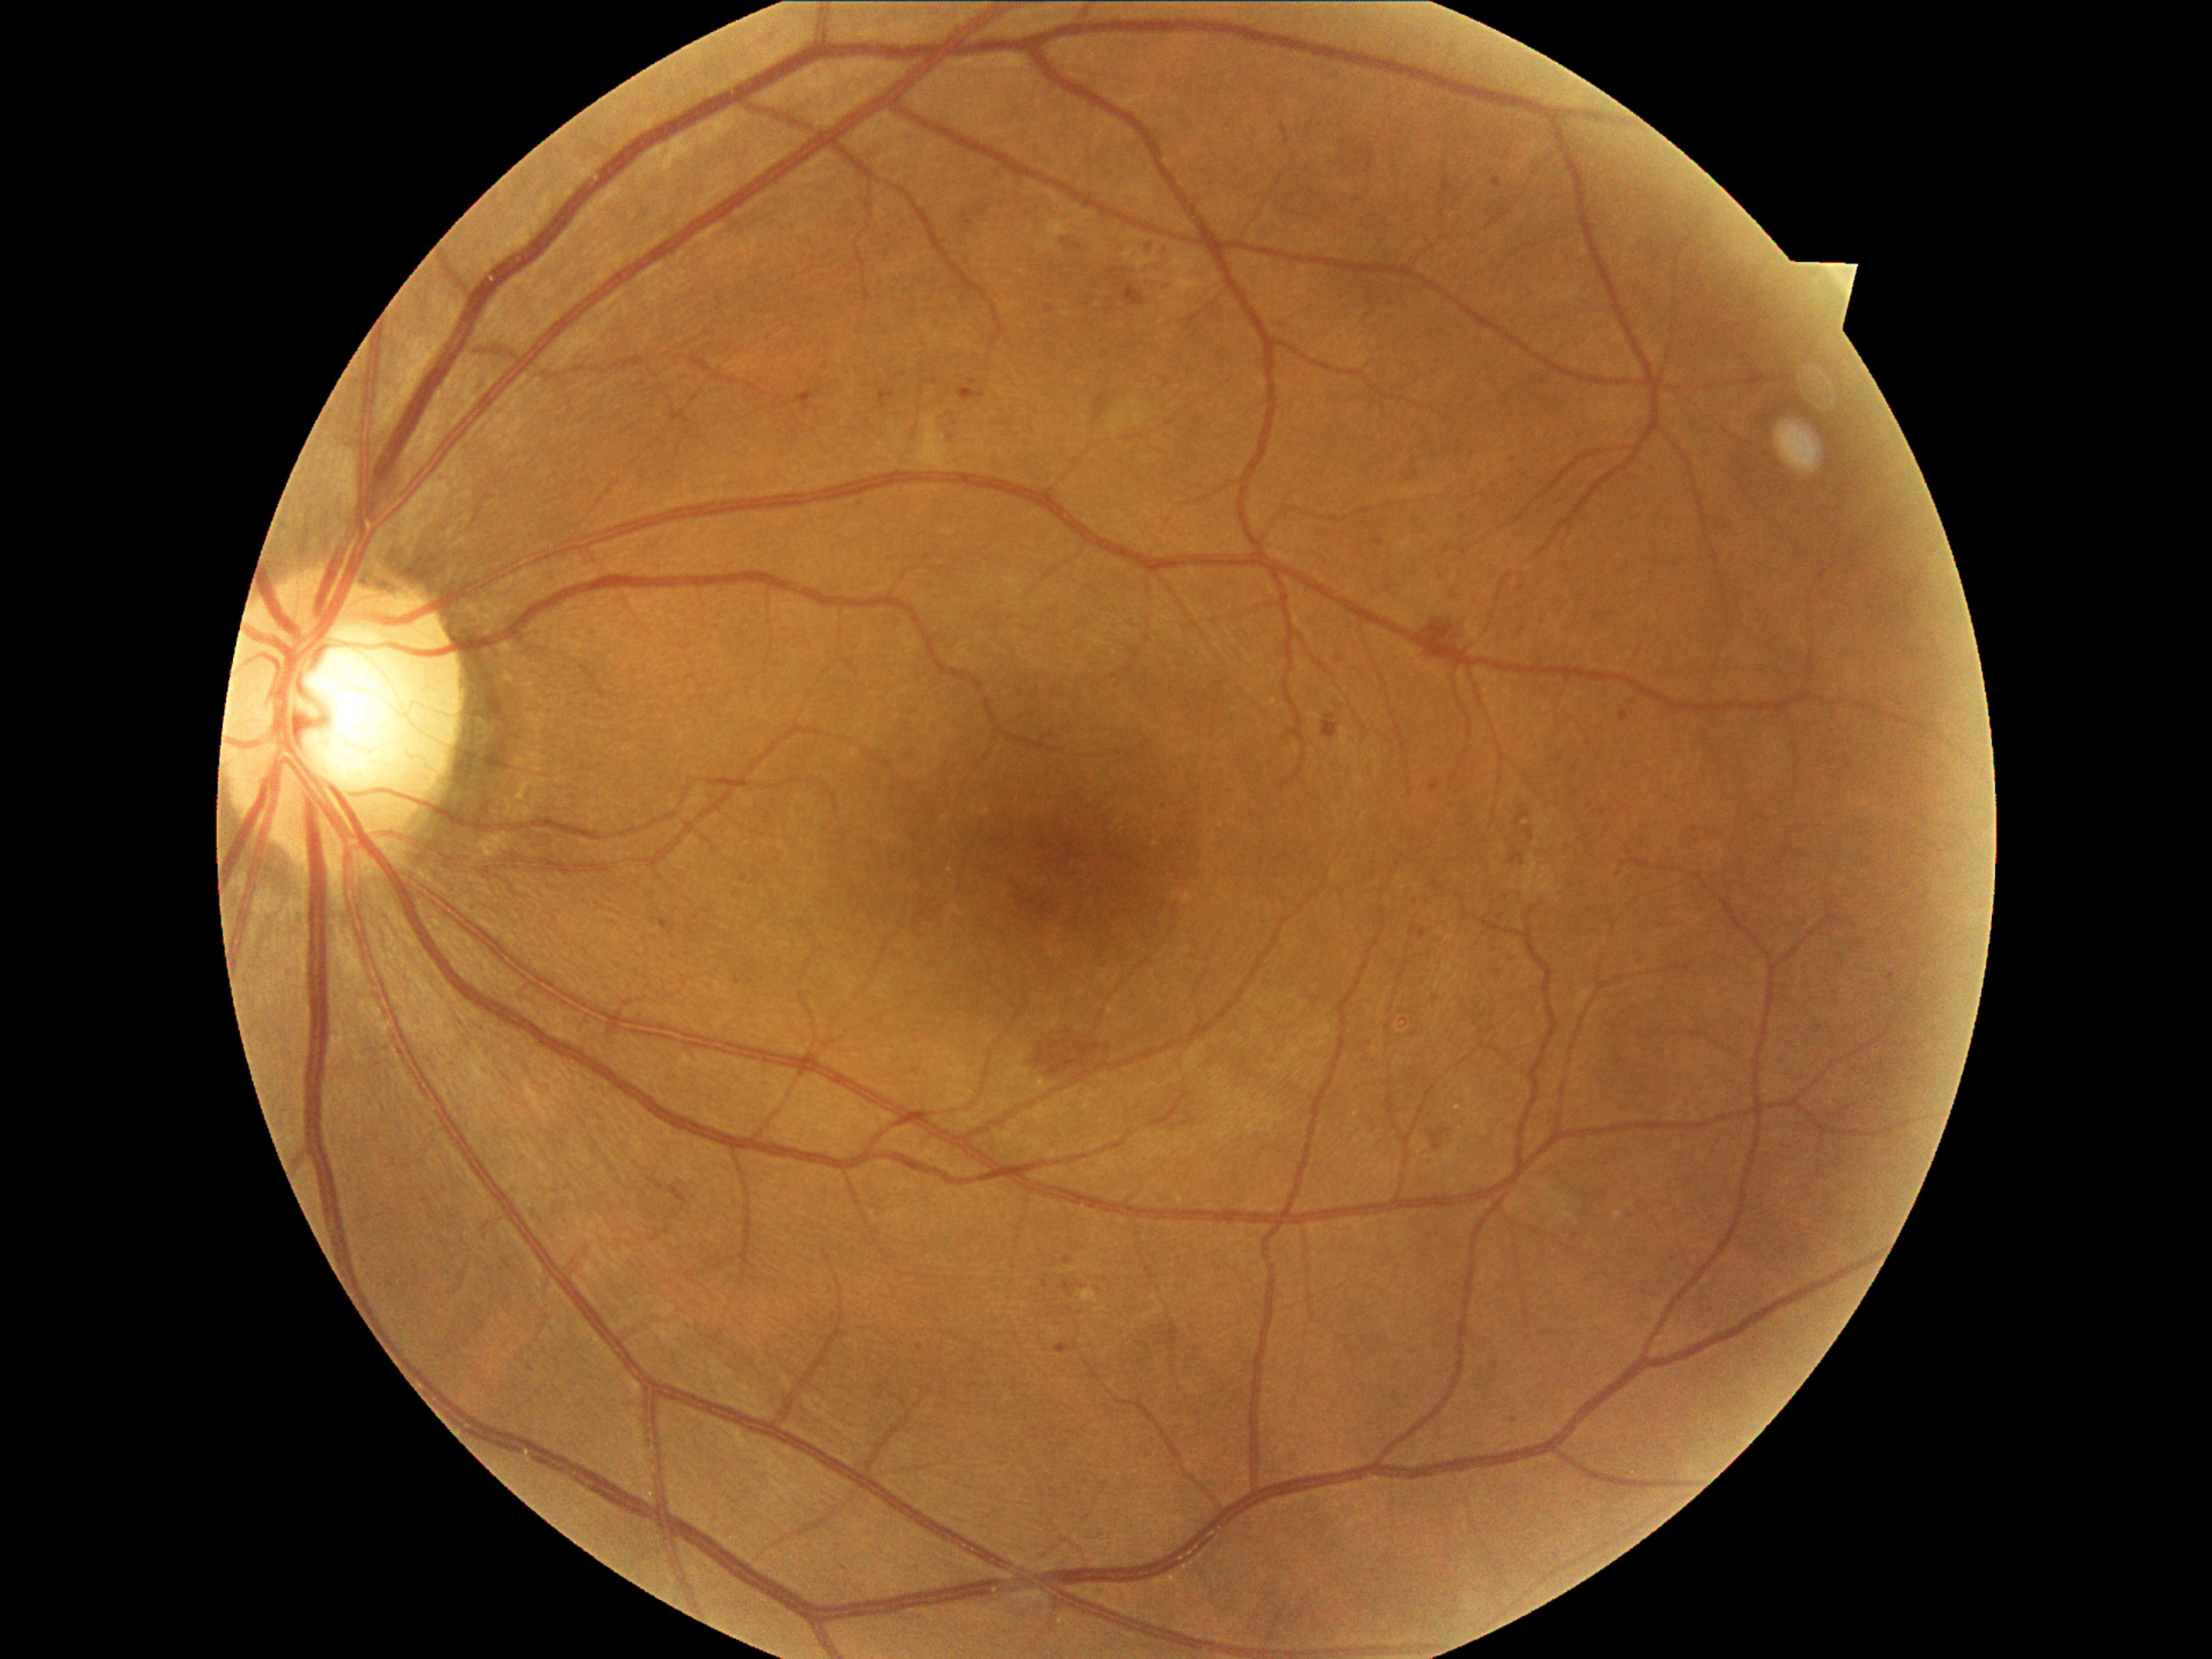

{"partial": true, "dr_grade": 2, "dr_grade_name": "moderate NPDR", "lesions": {"ma": [[1056, 1344, 1071, 1353], [1064, 1257, 1073, 1264], [658, 919, 675, 933], [1045, 305, 1056, 315], [1493, 178, 1503, 189], [969, 378, 979, 385], [1044, 1279, 1049, 1289], [1080, 1286, 1088, 1291], [1062, 1283, 1074, 1293]], "ma_small_approx": [[1513, 460], [956, 424], [1625, 864], [1288, 142], [1404, 1022], [915, 1070], [1064, 243]]}}